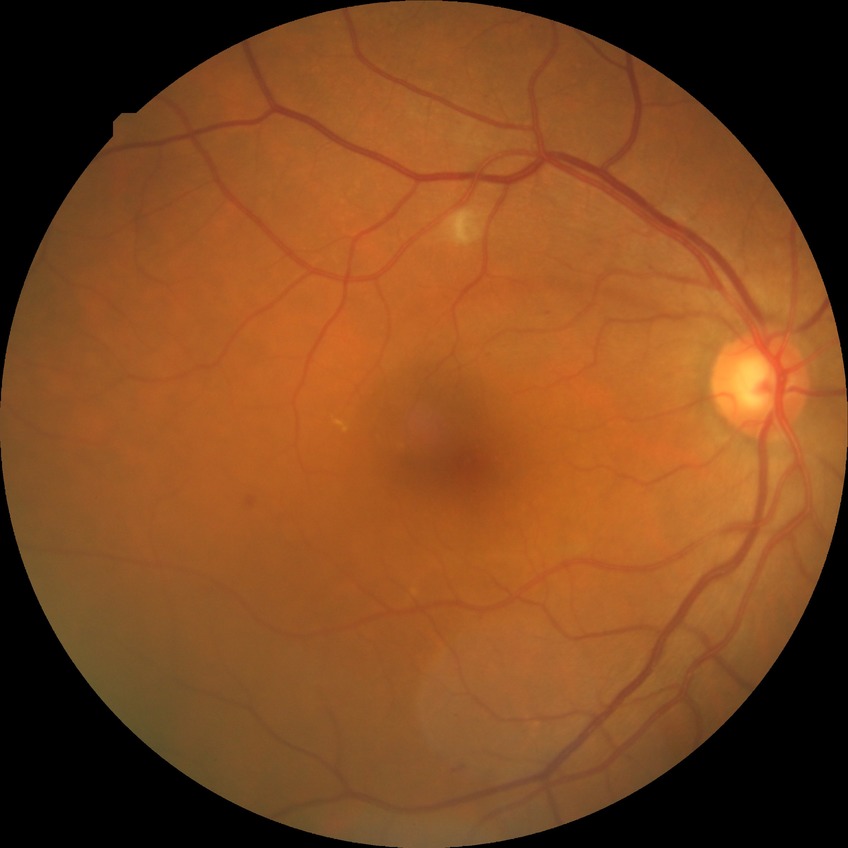

Diabetic retinopathy (DR): PPDR (pre-proliferative diabetic retinopathy).